Pediatric wide-field fundus photograph · acquired on the Clarity RetCam 3 · image size 640x480: 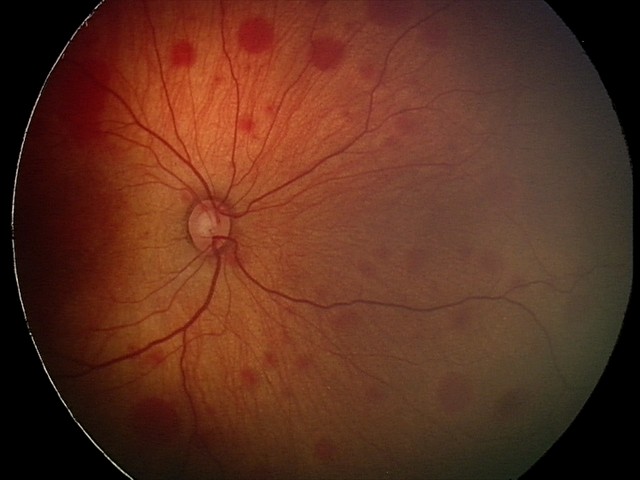

Screening diagnosis: retinal hemorrhages.